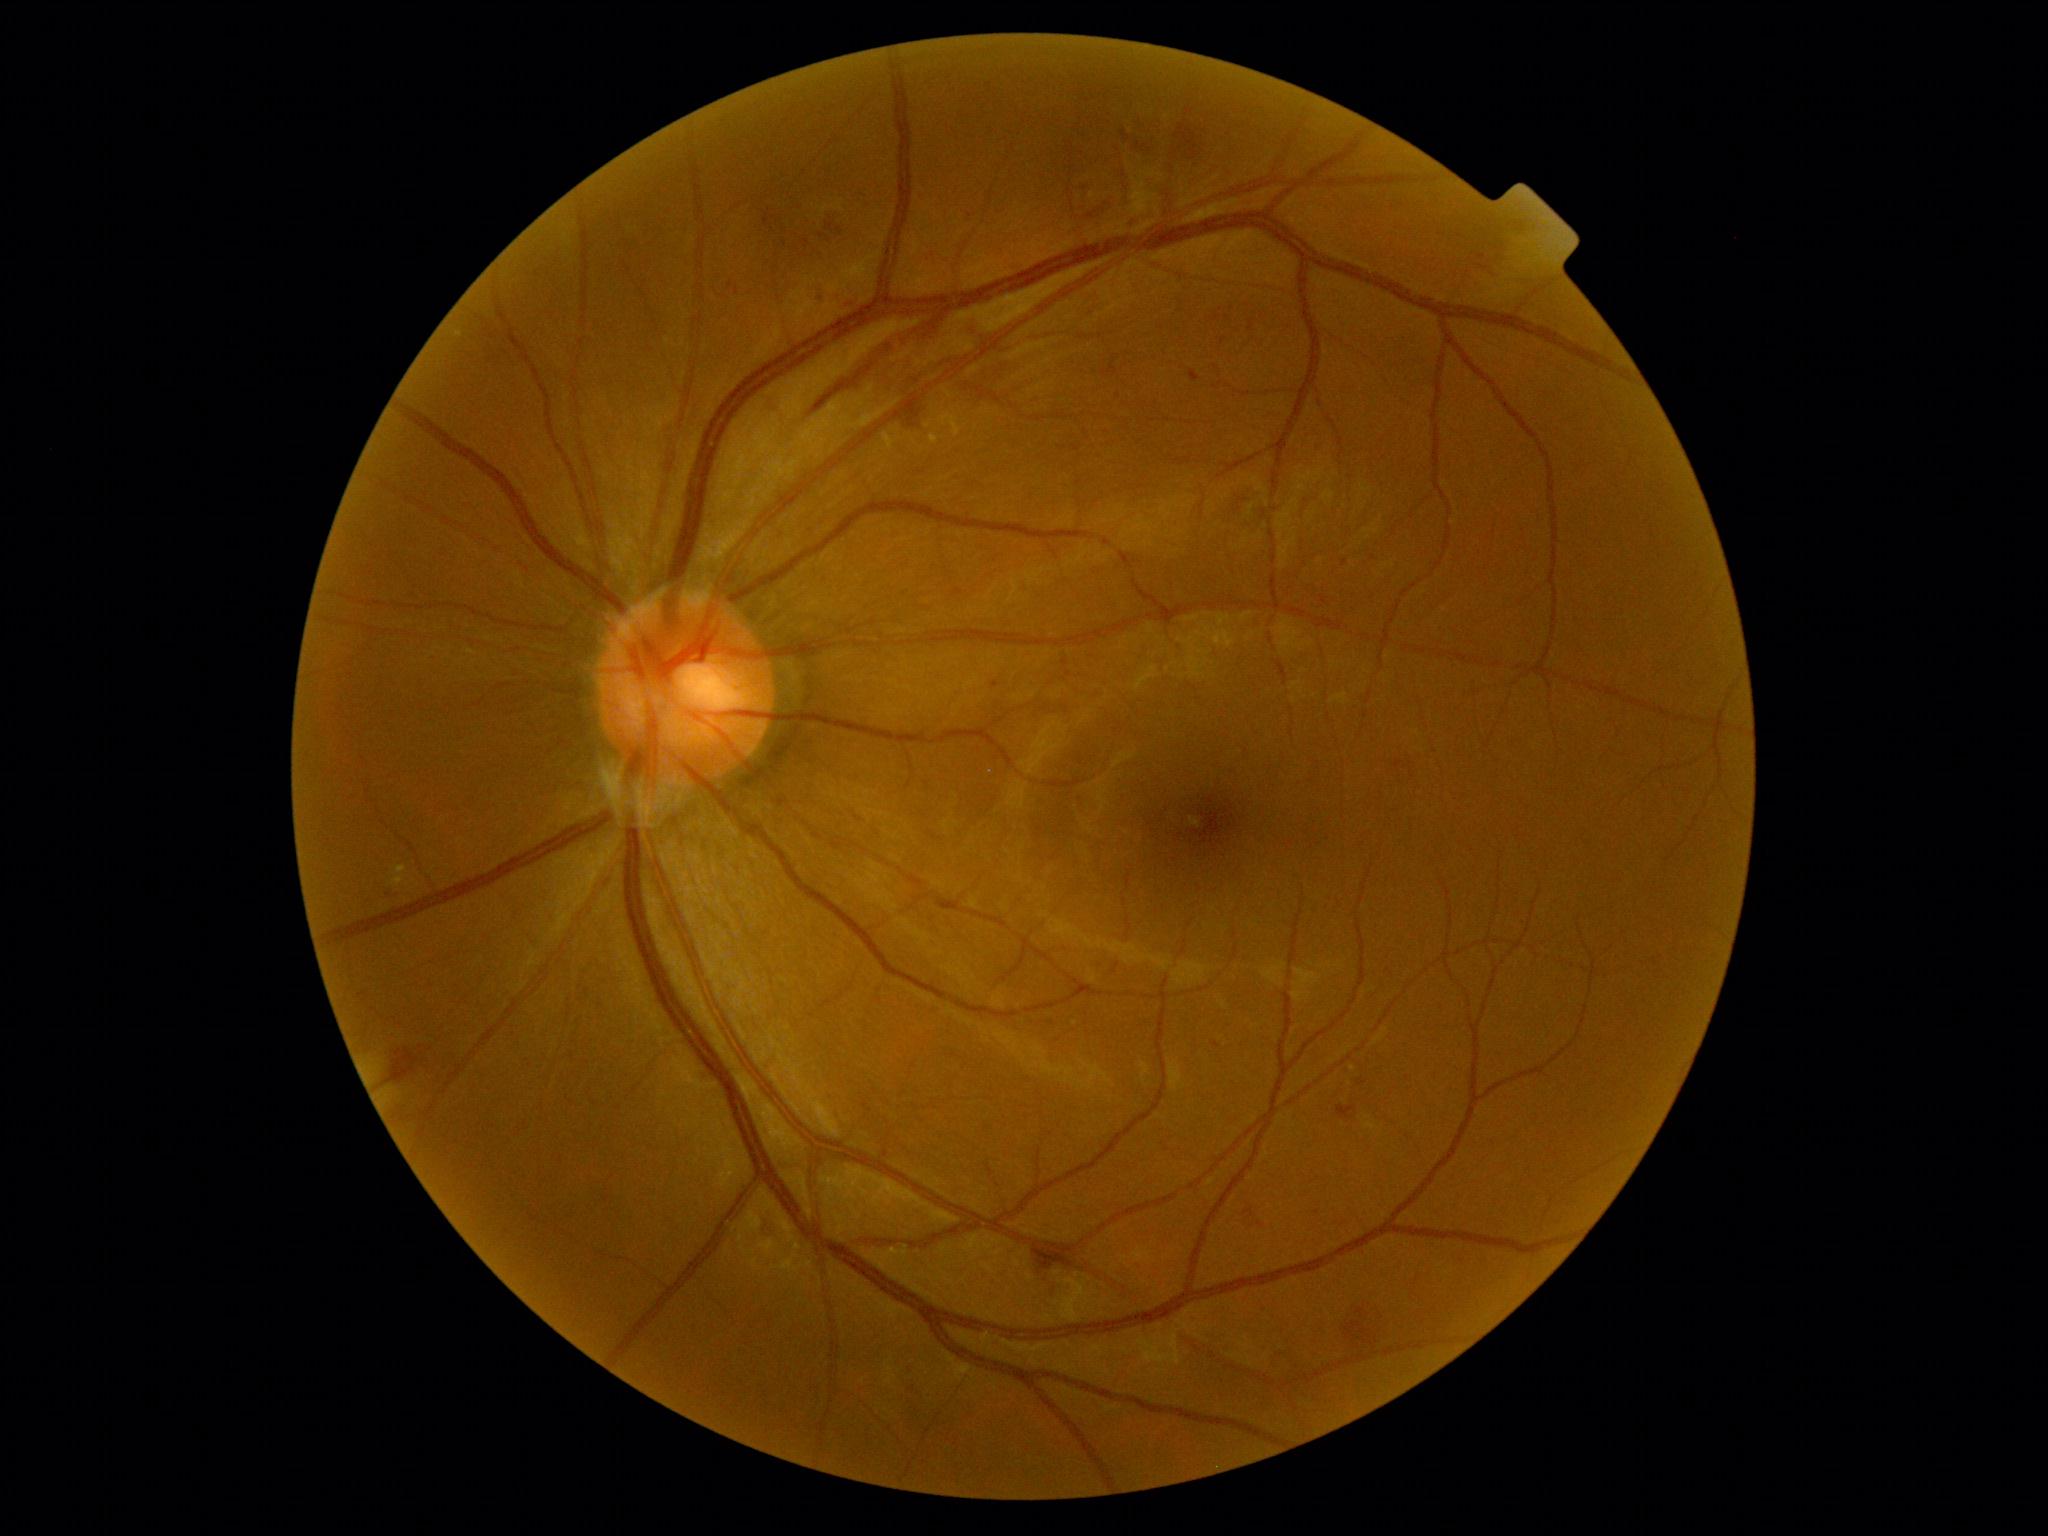

DR grade: 2 — more than just microaneurysms but less than severe NPDR
Selected lesions:
* HEs (subset): {"x1": 1479, "y1": 265, "x2": 1490, "y2": 271} | {"x1": 1189, "y1": 371, "x2": 1201, "y2": 382} | {"x1": 1133, "y1": 113, "x2": 1163, "y2": 163} | {"x1": 1245, "y1": 1210, "x2": 1265, "y2": 1229} | {"x1": 1396, "y1": 760, "x2": 1403, "y2": 769} | {"x1": 1337, "y1": 1105, "x2": 1357, "y2": 1120} | {"x1": 1185, "y1": 123, "x2": 1202, "y2": 168} | {"x1": 1082, "y1": 200, "x2": 1118, "y2": 226}
* Small HEs approximately at 772:230 | 823:236 | 840:231